Fundus photo:
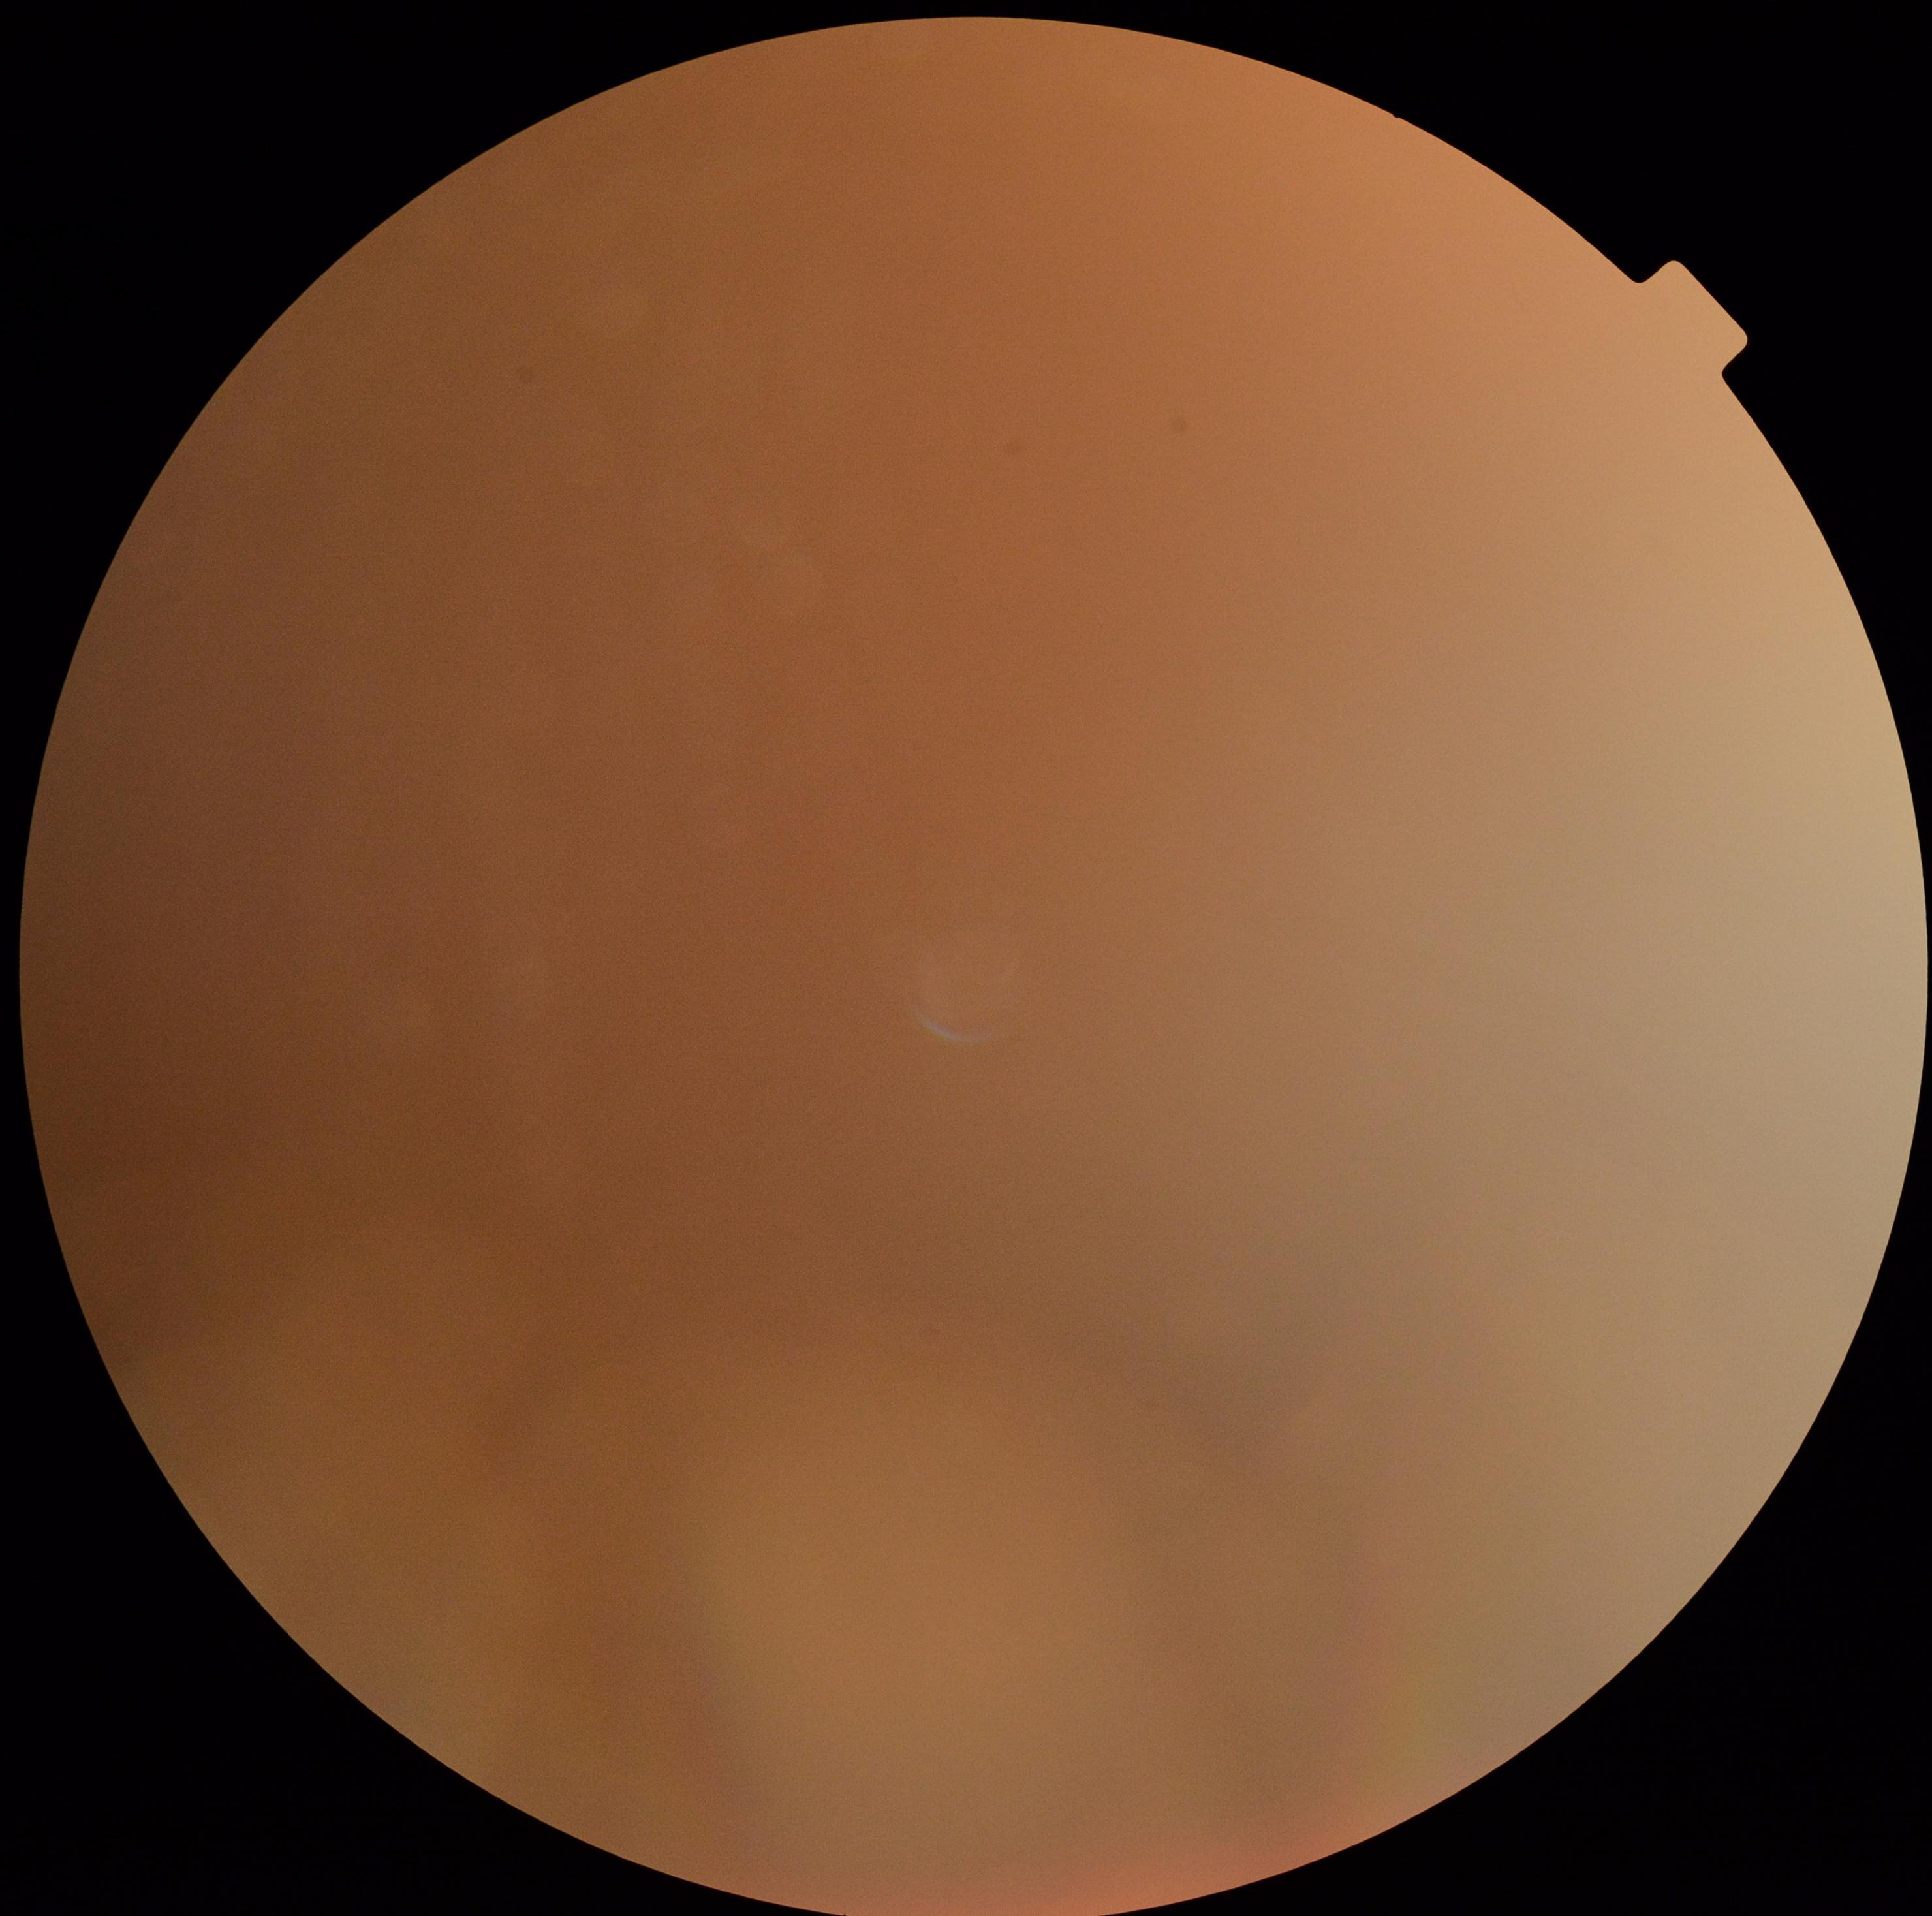
Image quality is insufficient for diabetic retinopathy assessment. DR grade: ungradable due to poor image quality.